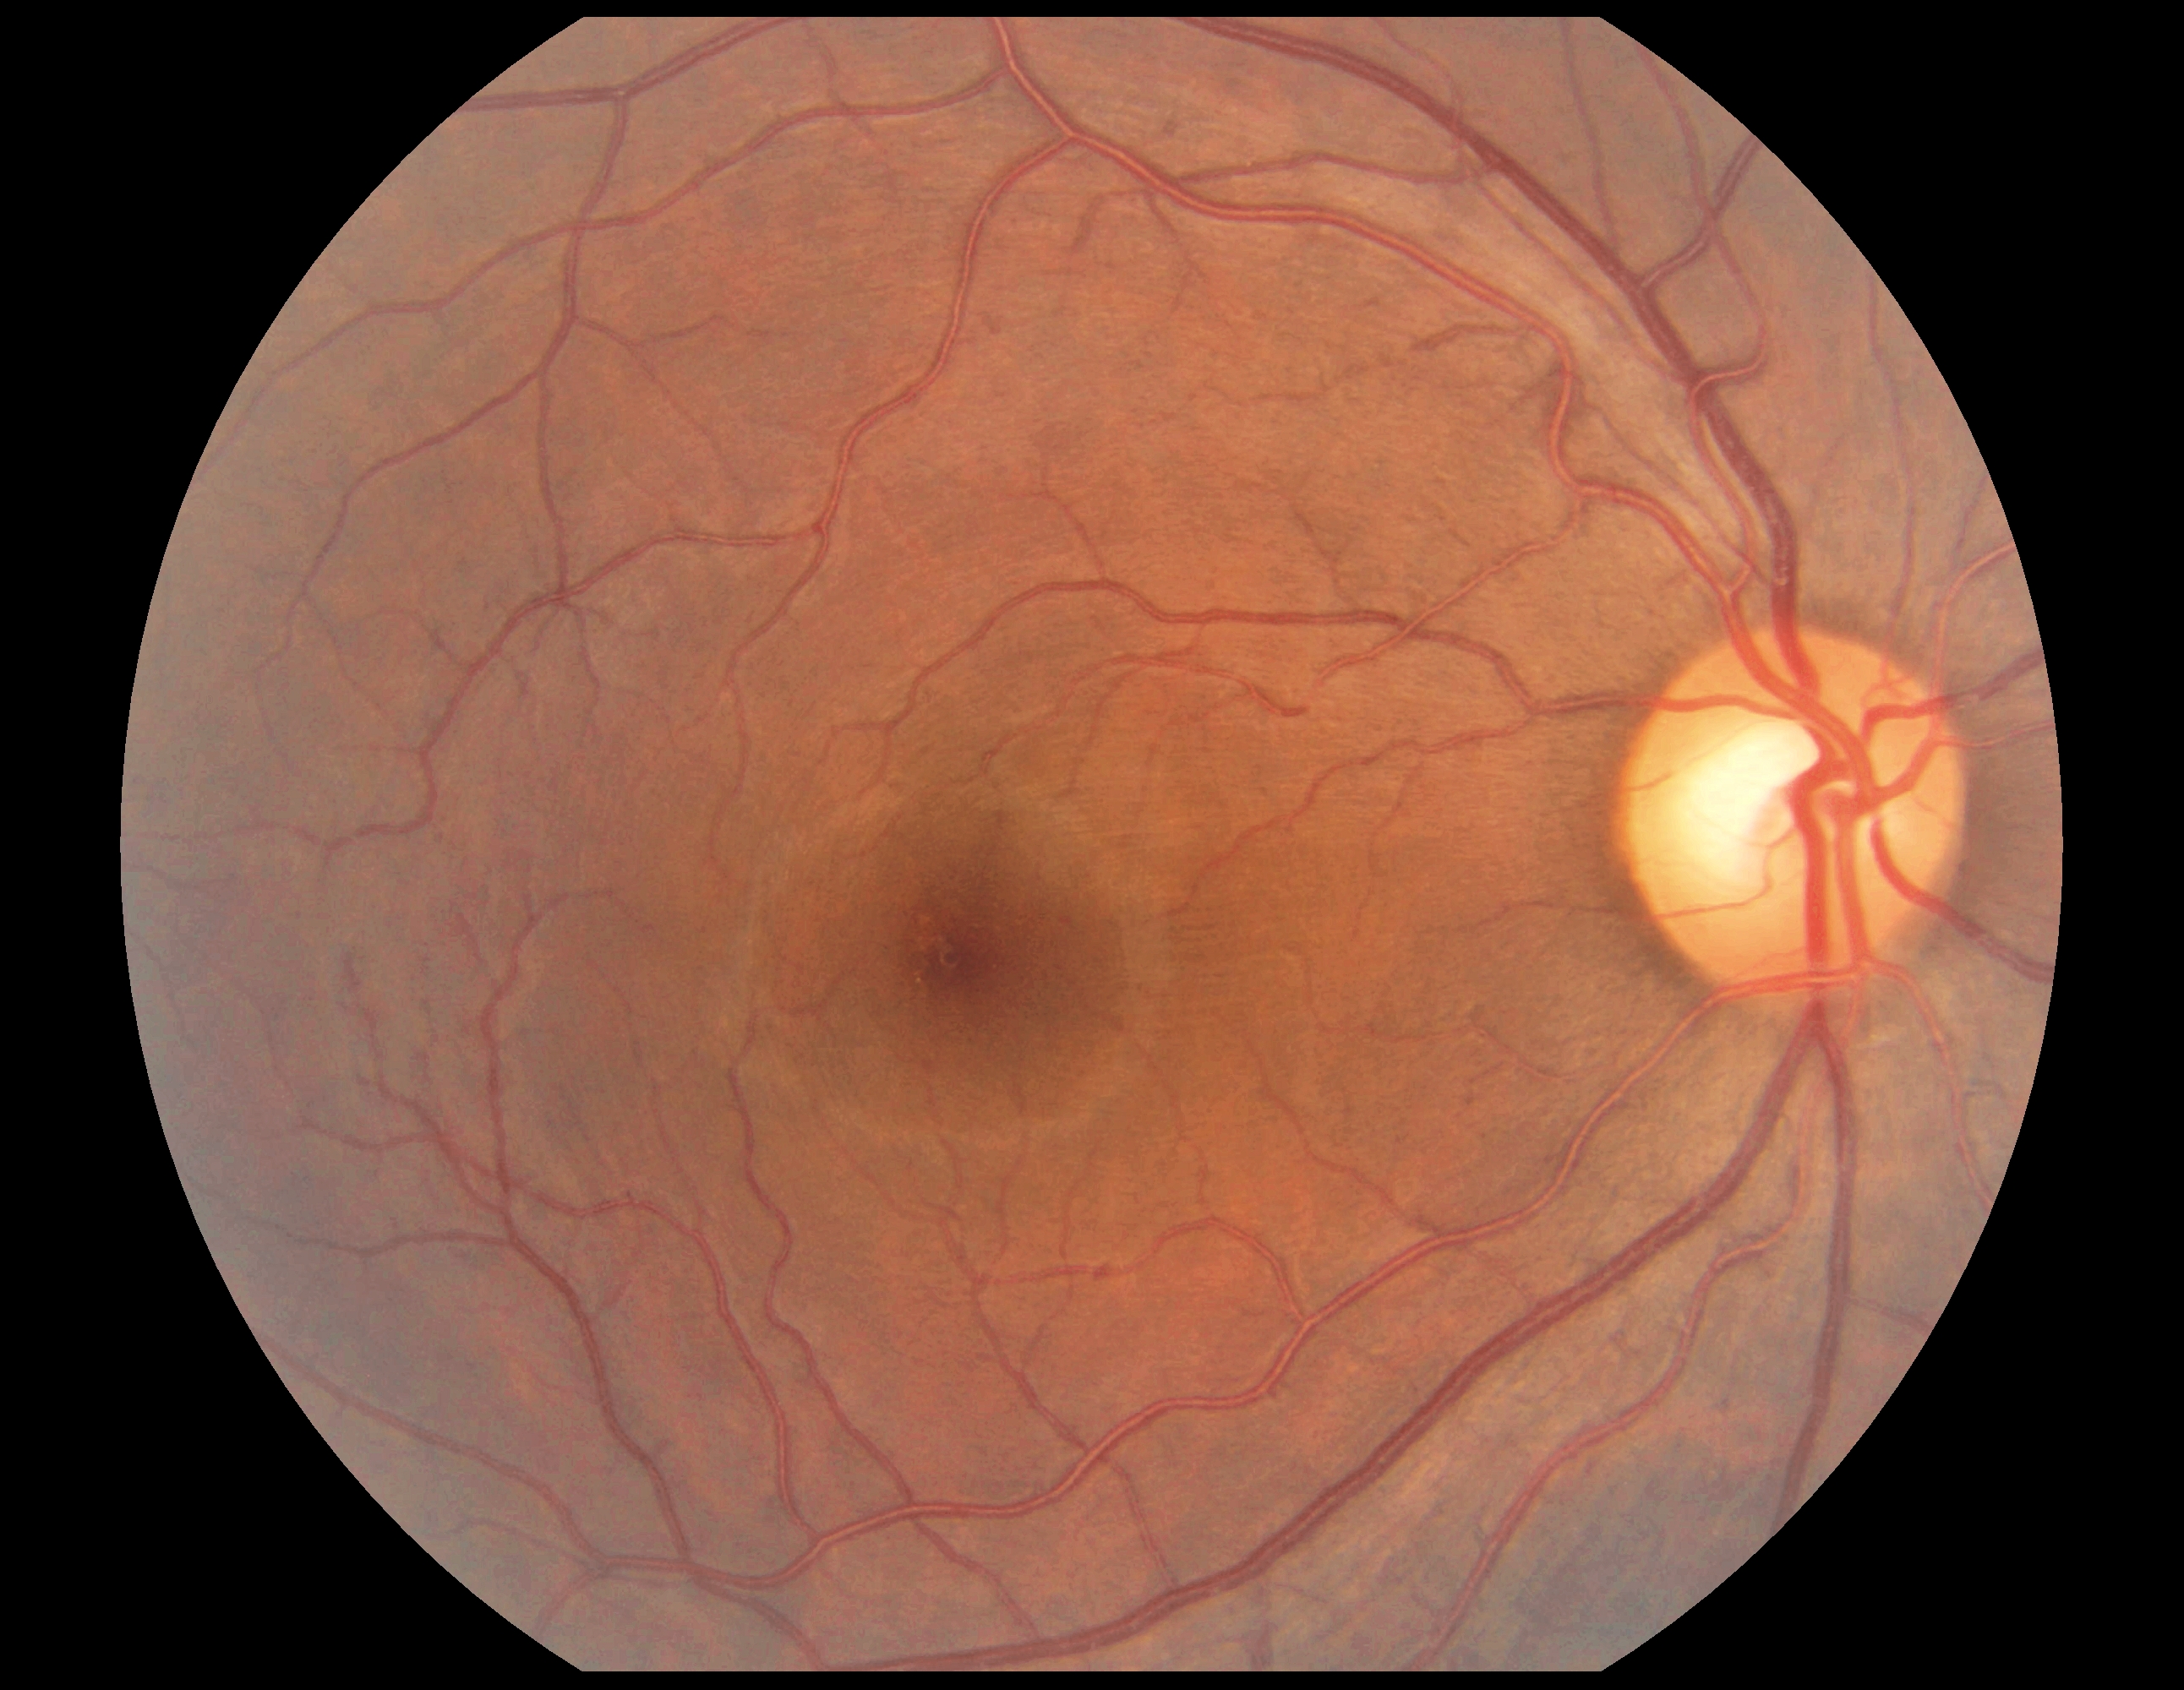
Diabetic retinopathy: no apparent diabetic retinopathy (grade 0).